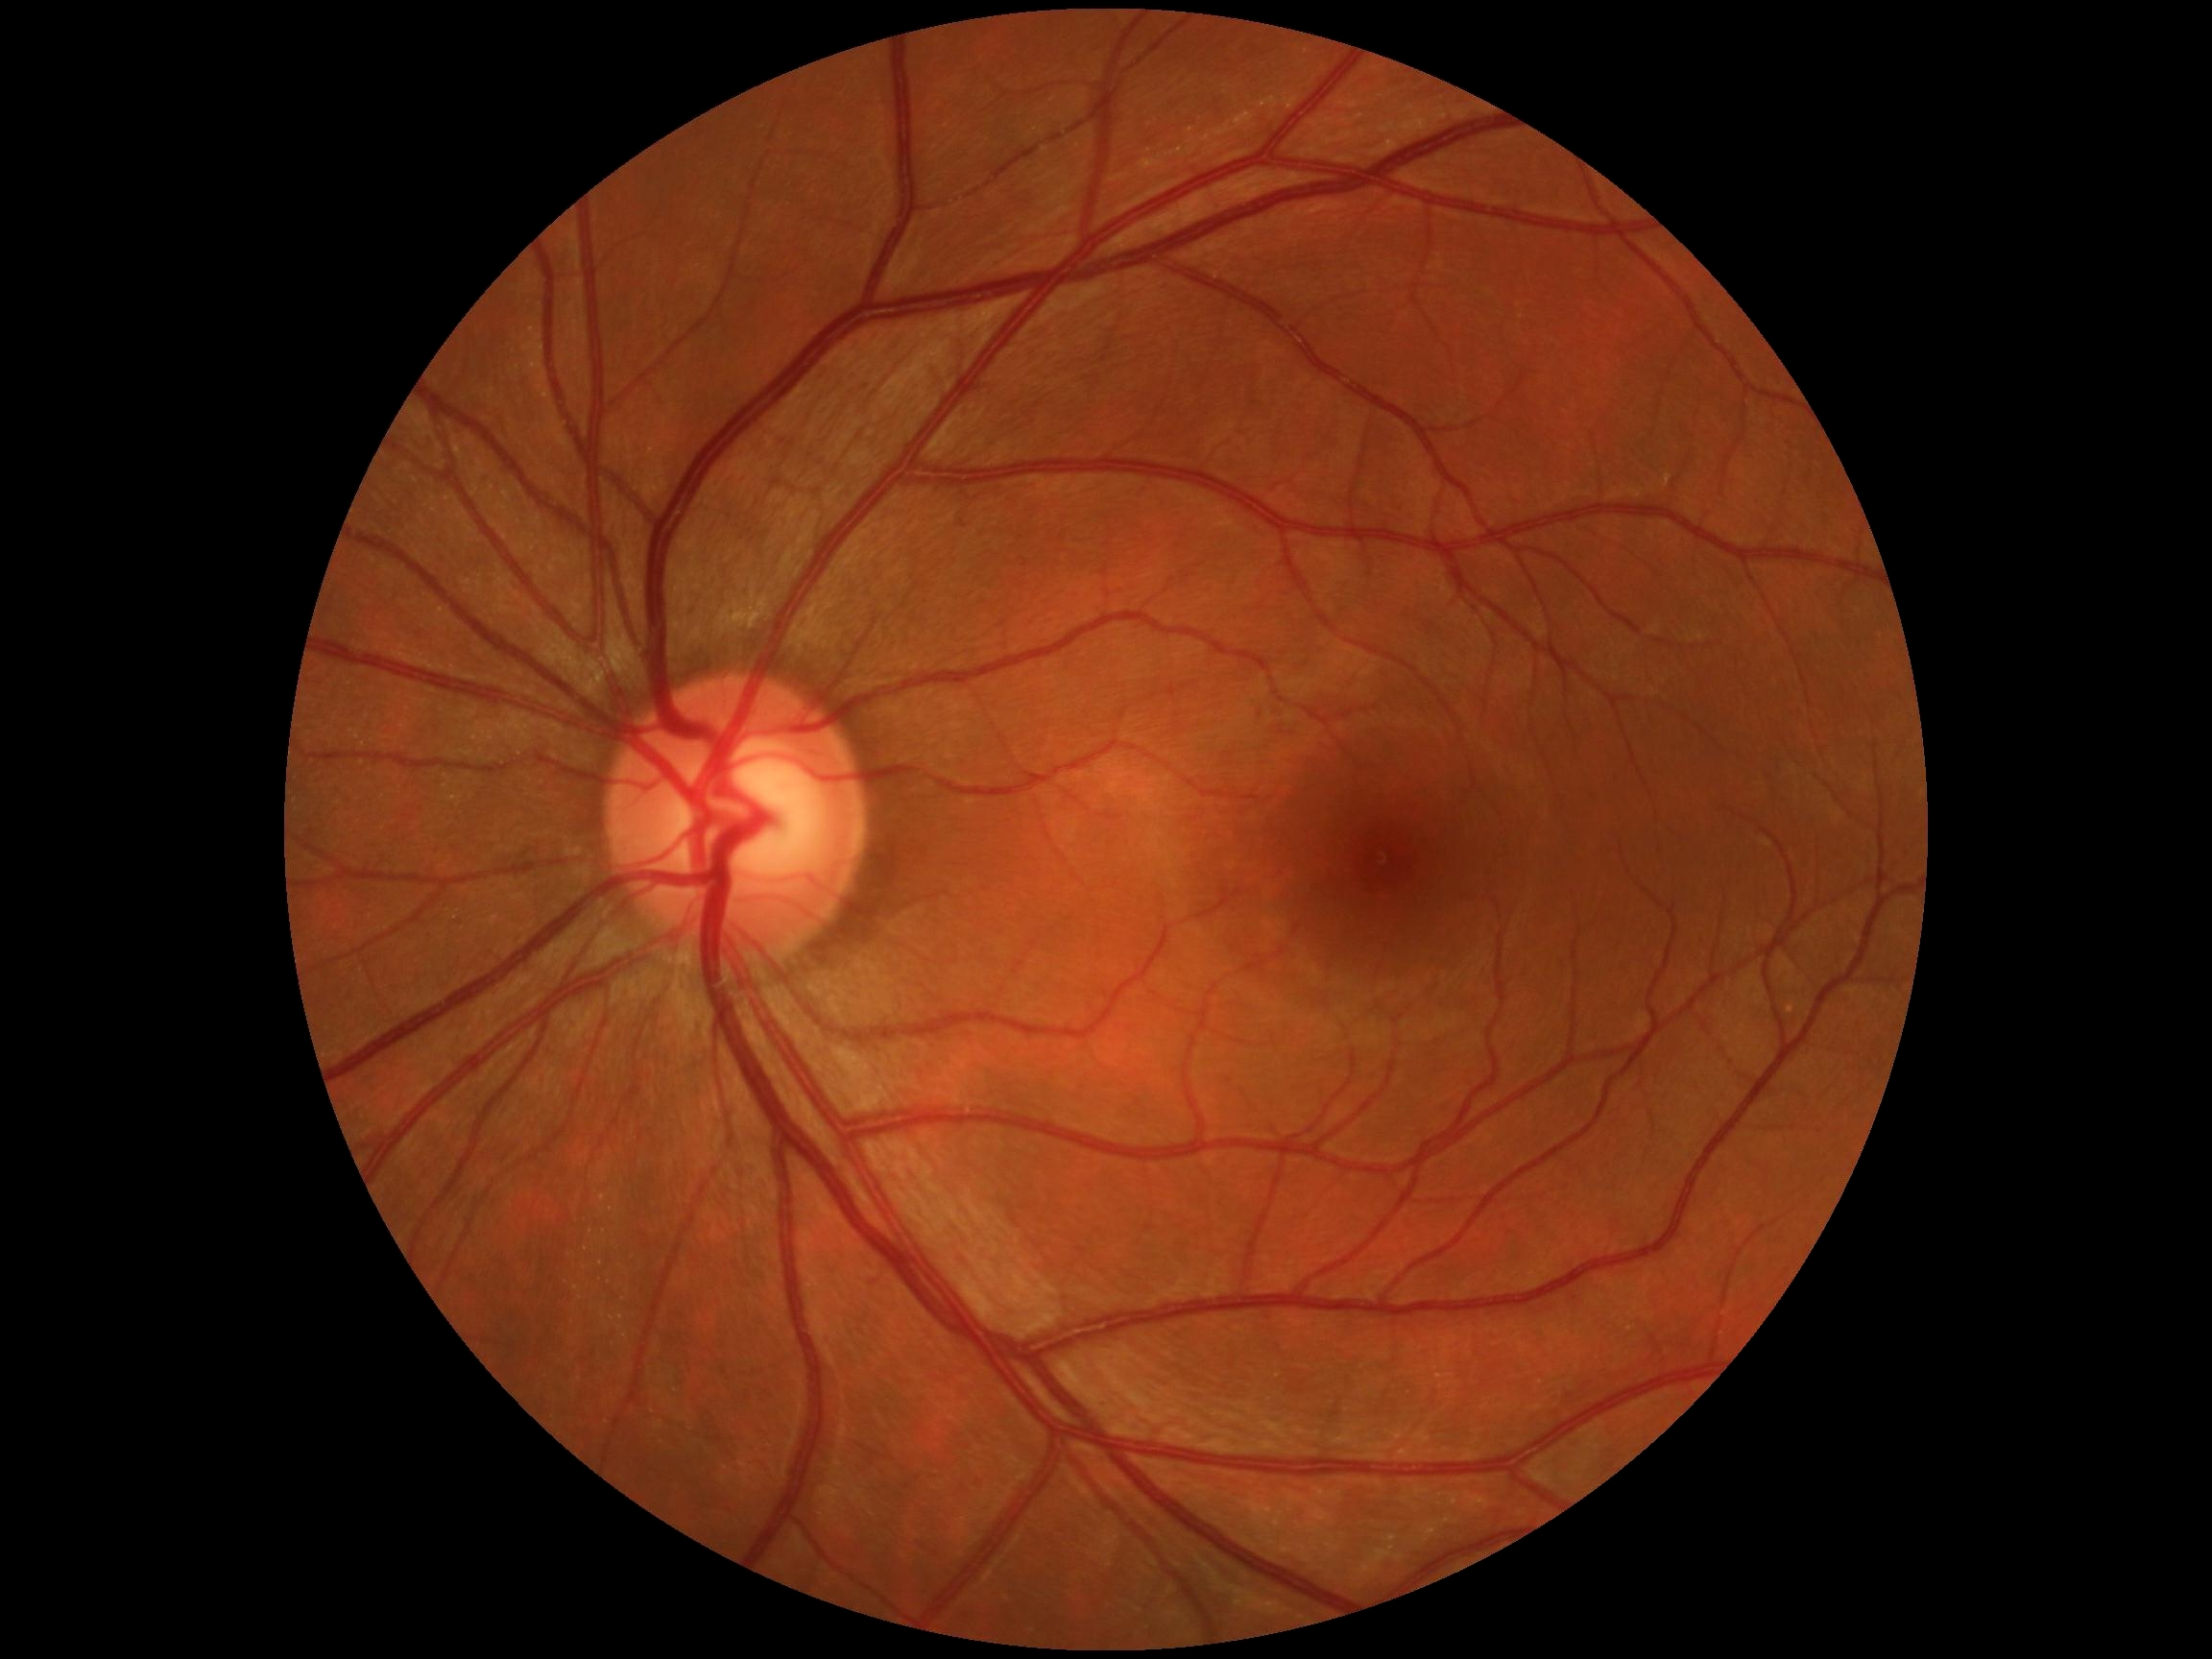 DR: grade 0 (no apparent retinopathy).